CFP:
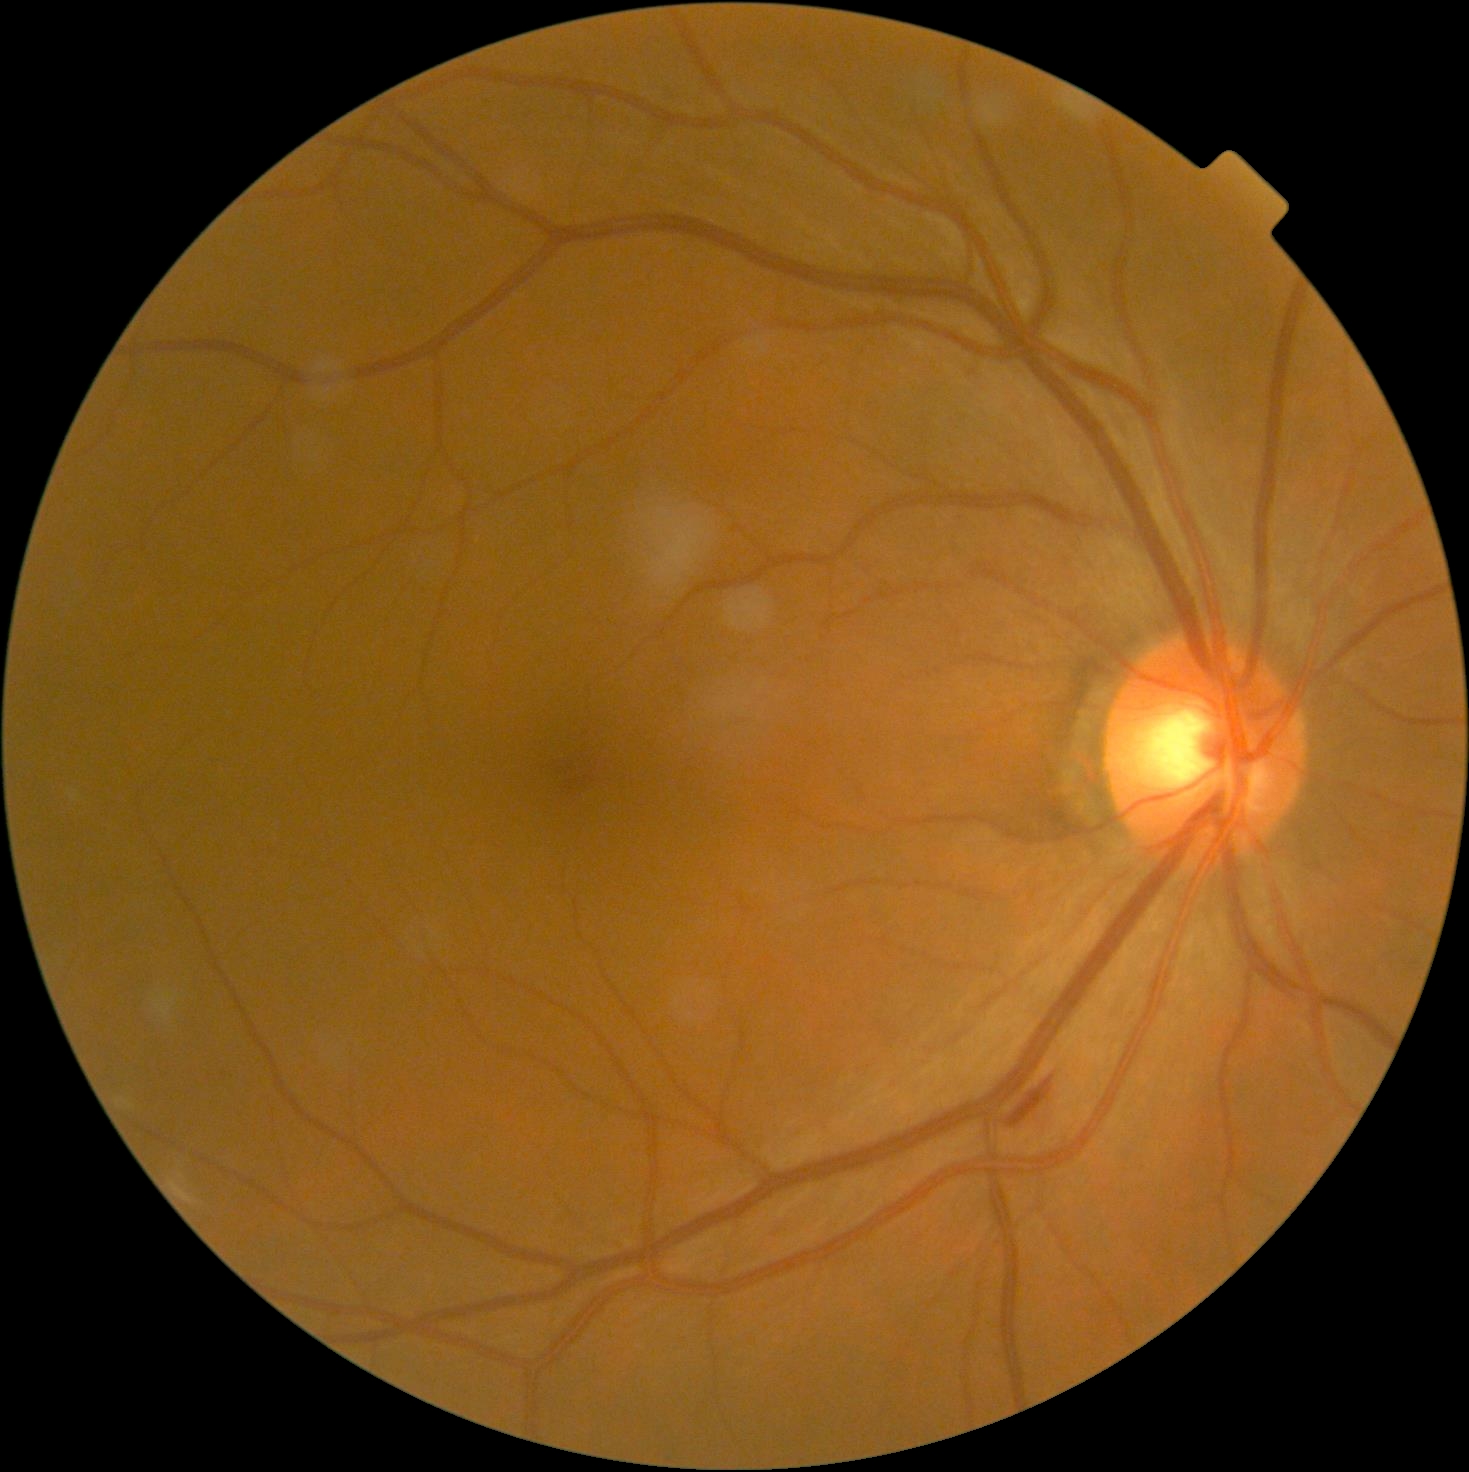
DR: moderate non-proliferative diabetic retinopathy (grade 2).